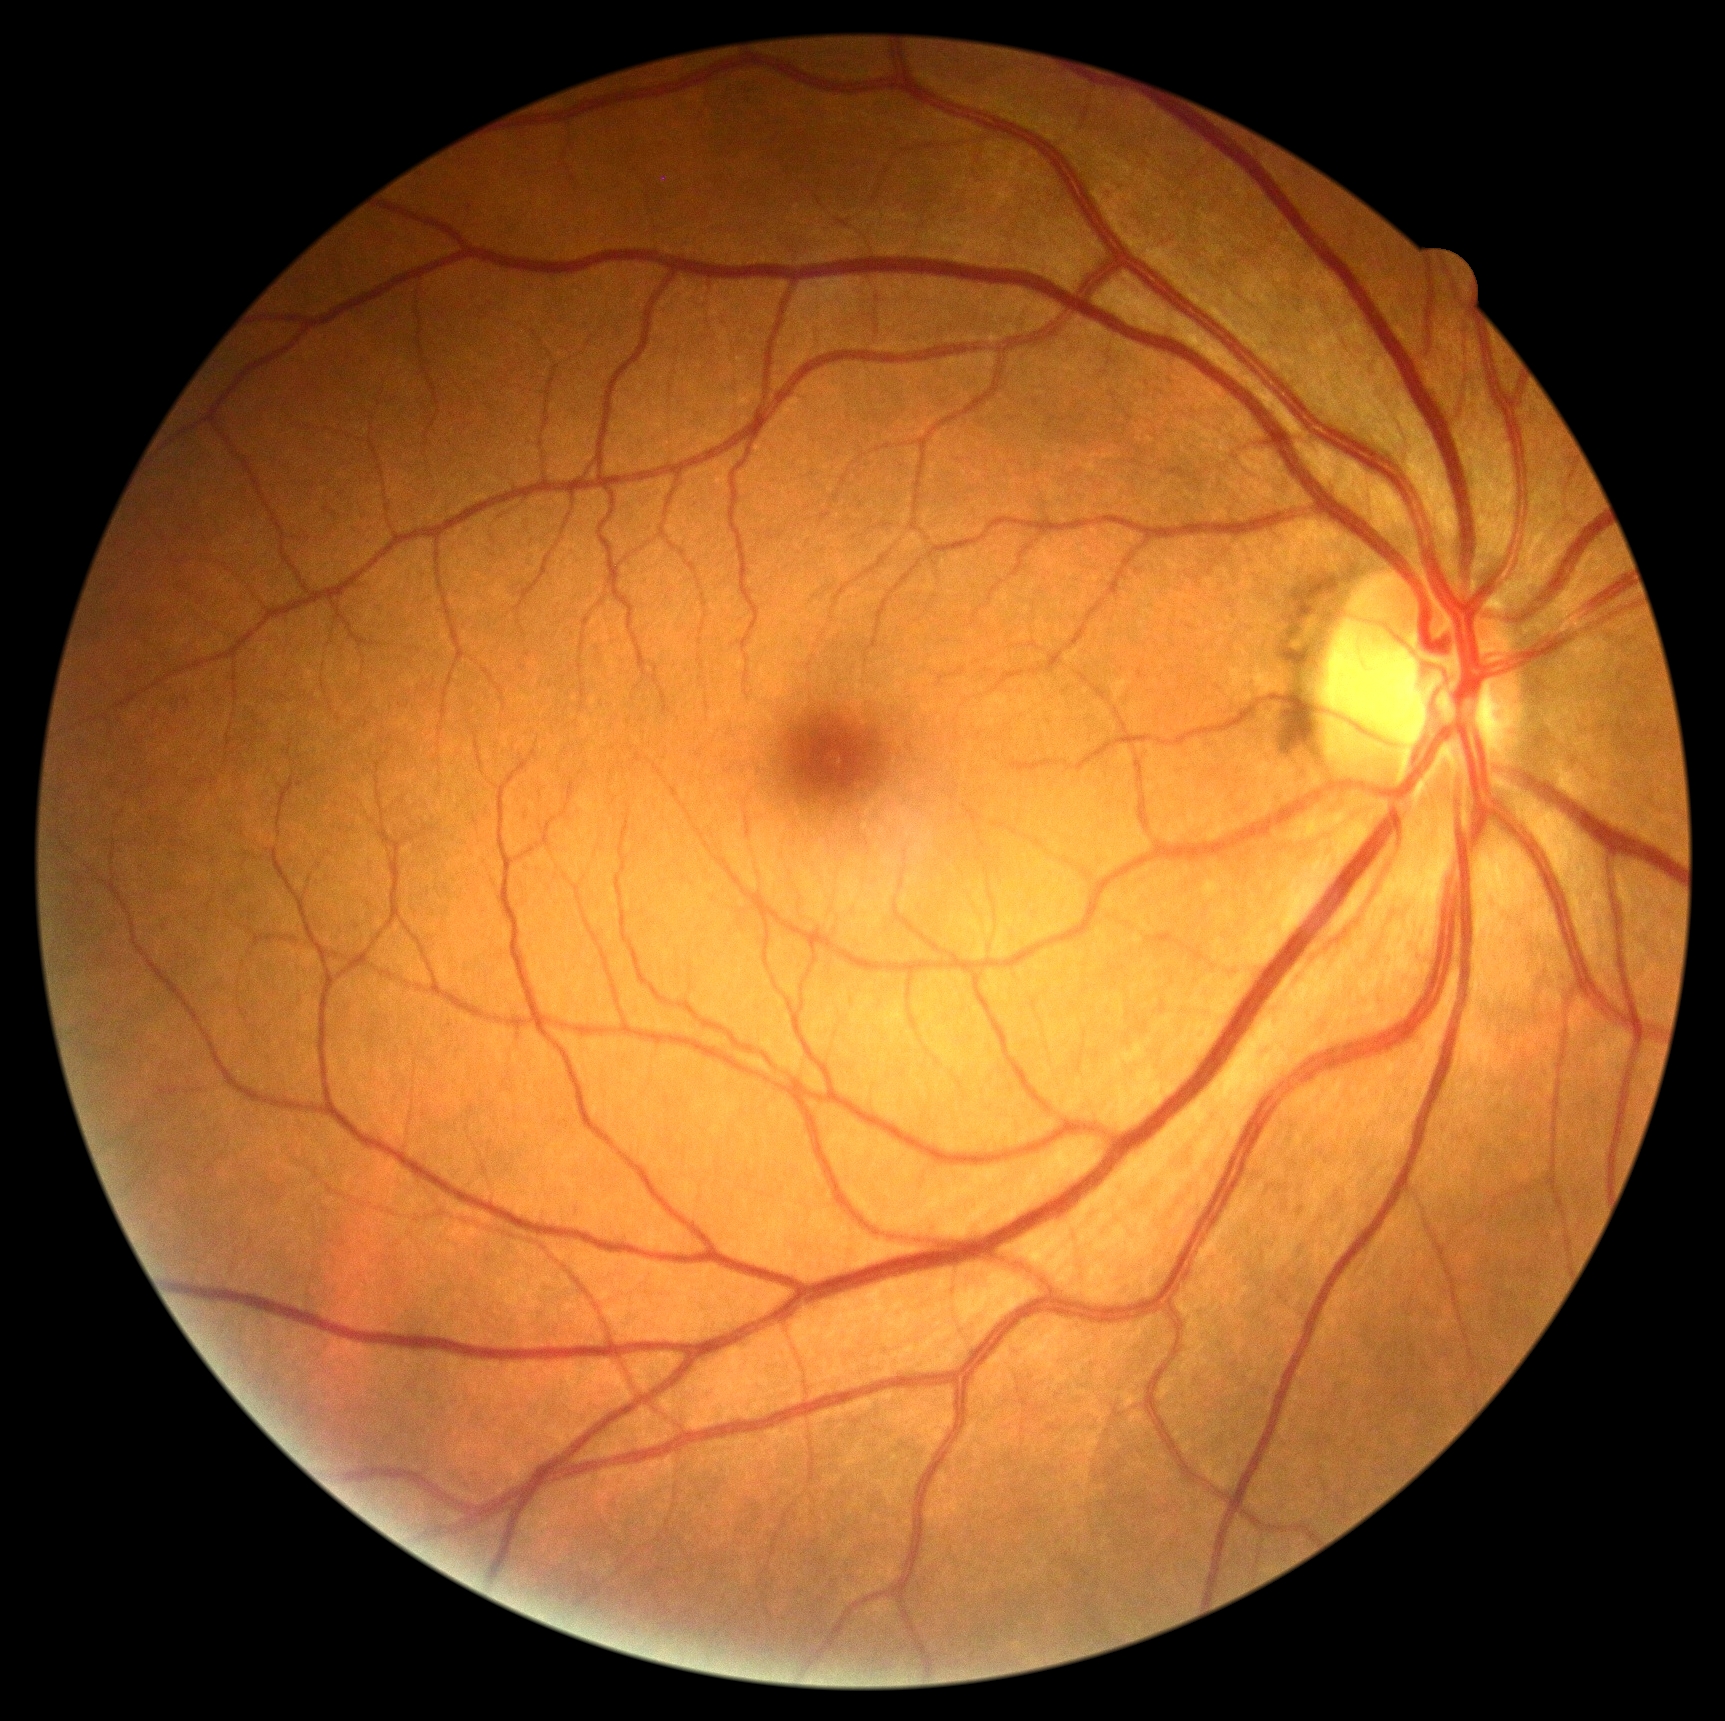 DR grade is 0 (no apparent retinopathy).